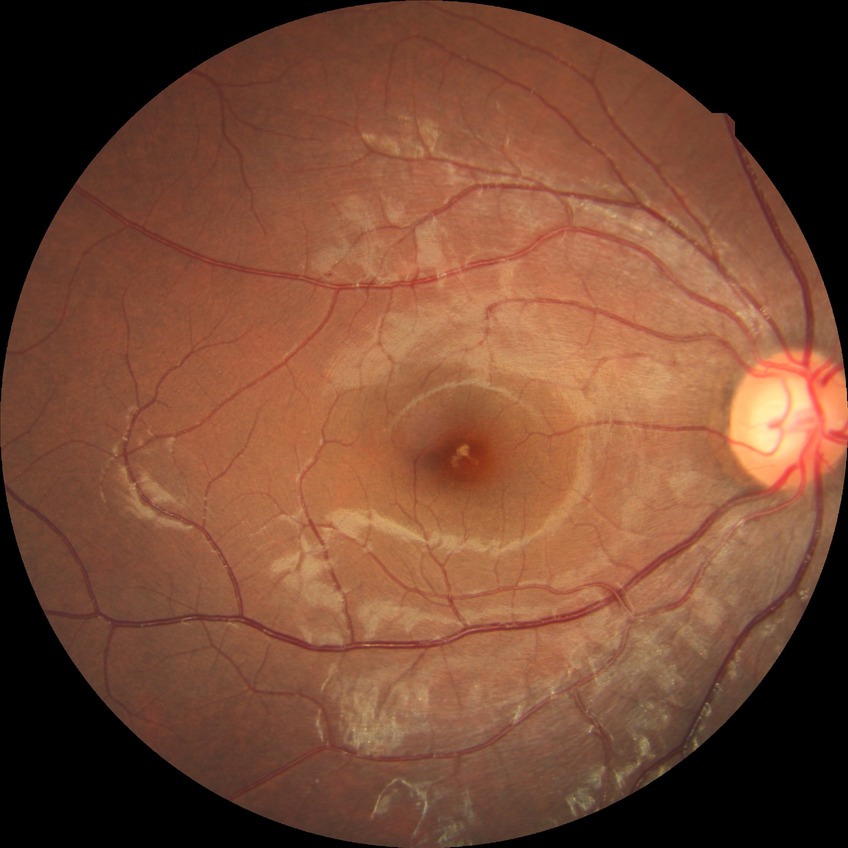 diabetic retinopathy stage = no diabetic retinopathy.